45° FOV. Image size 2352x1568
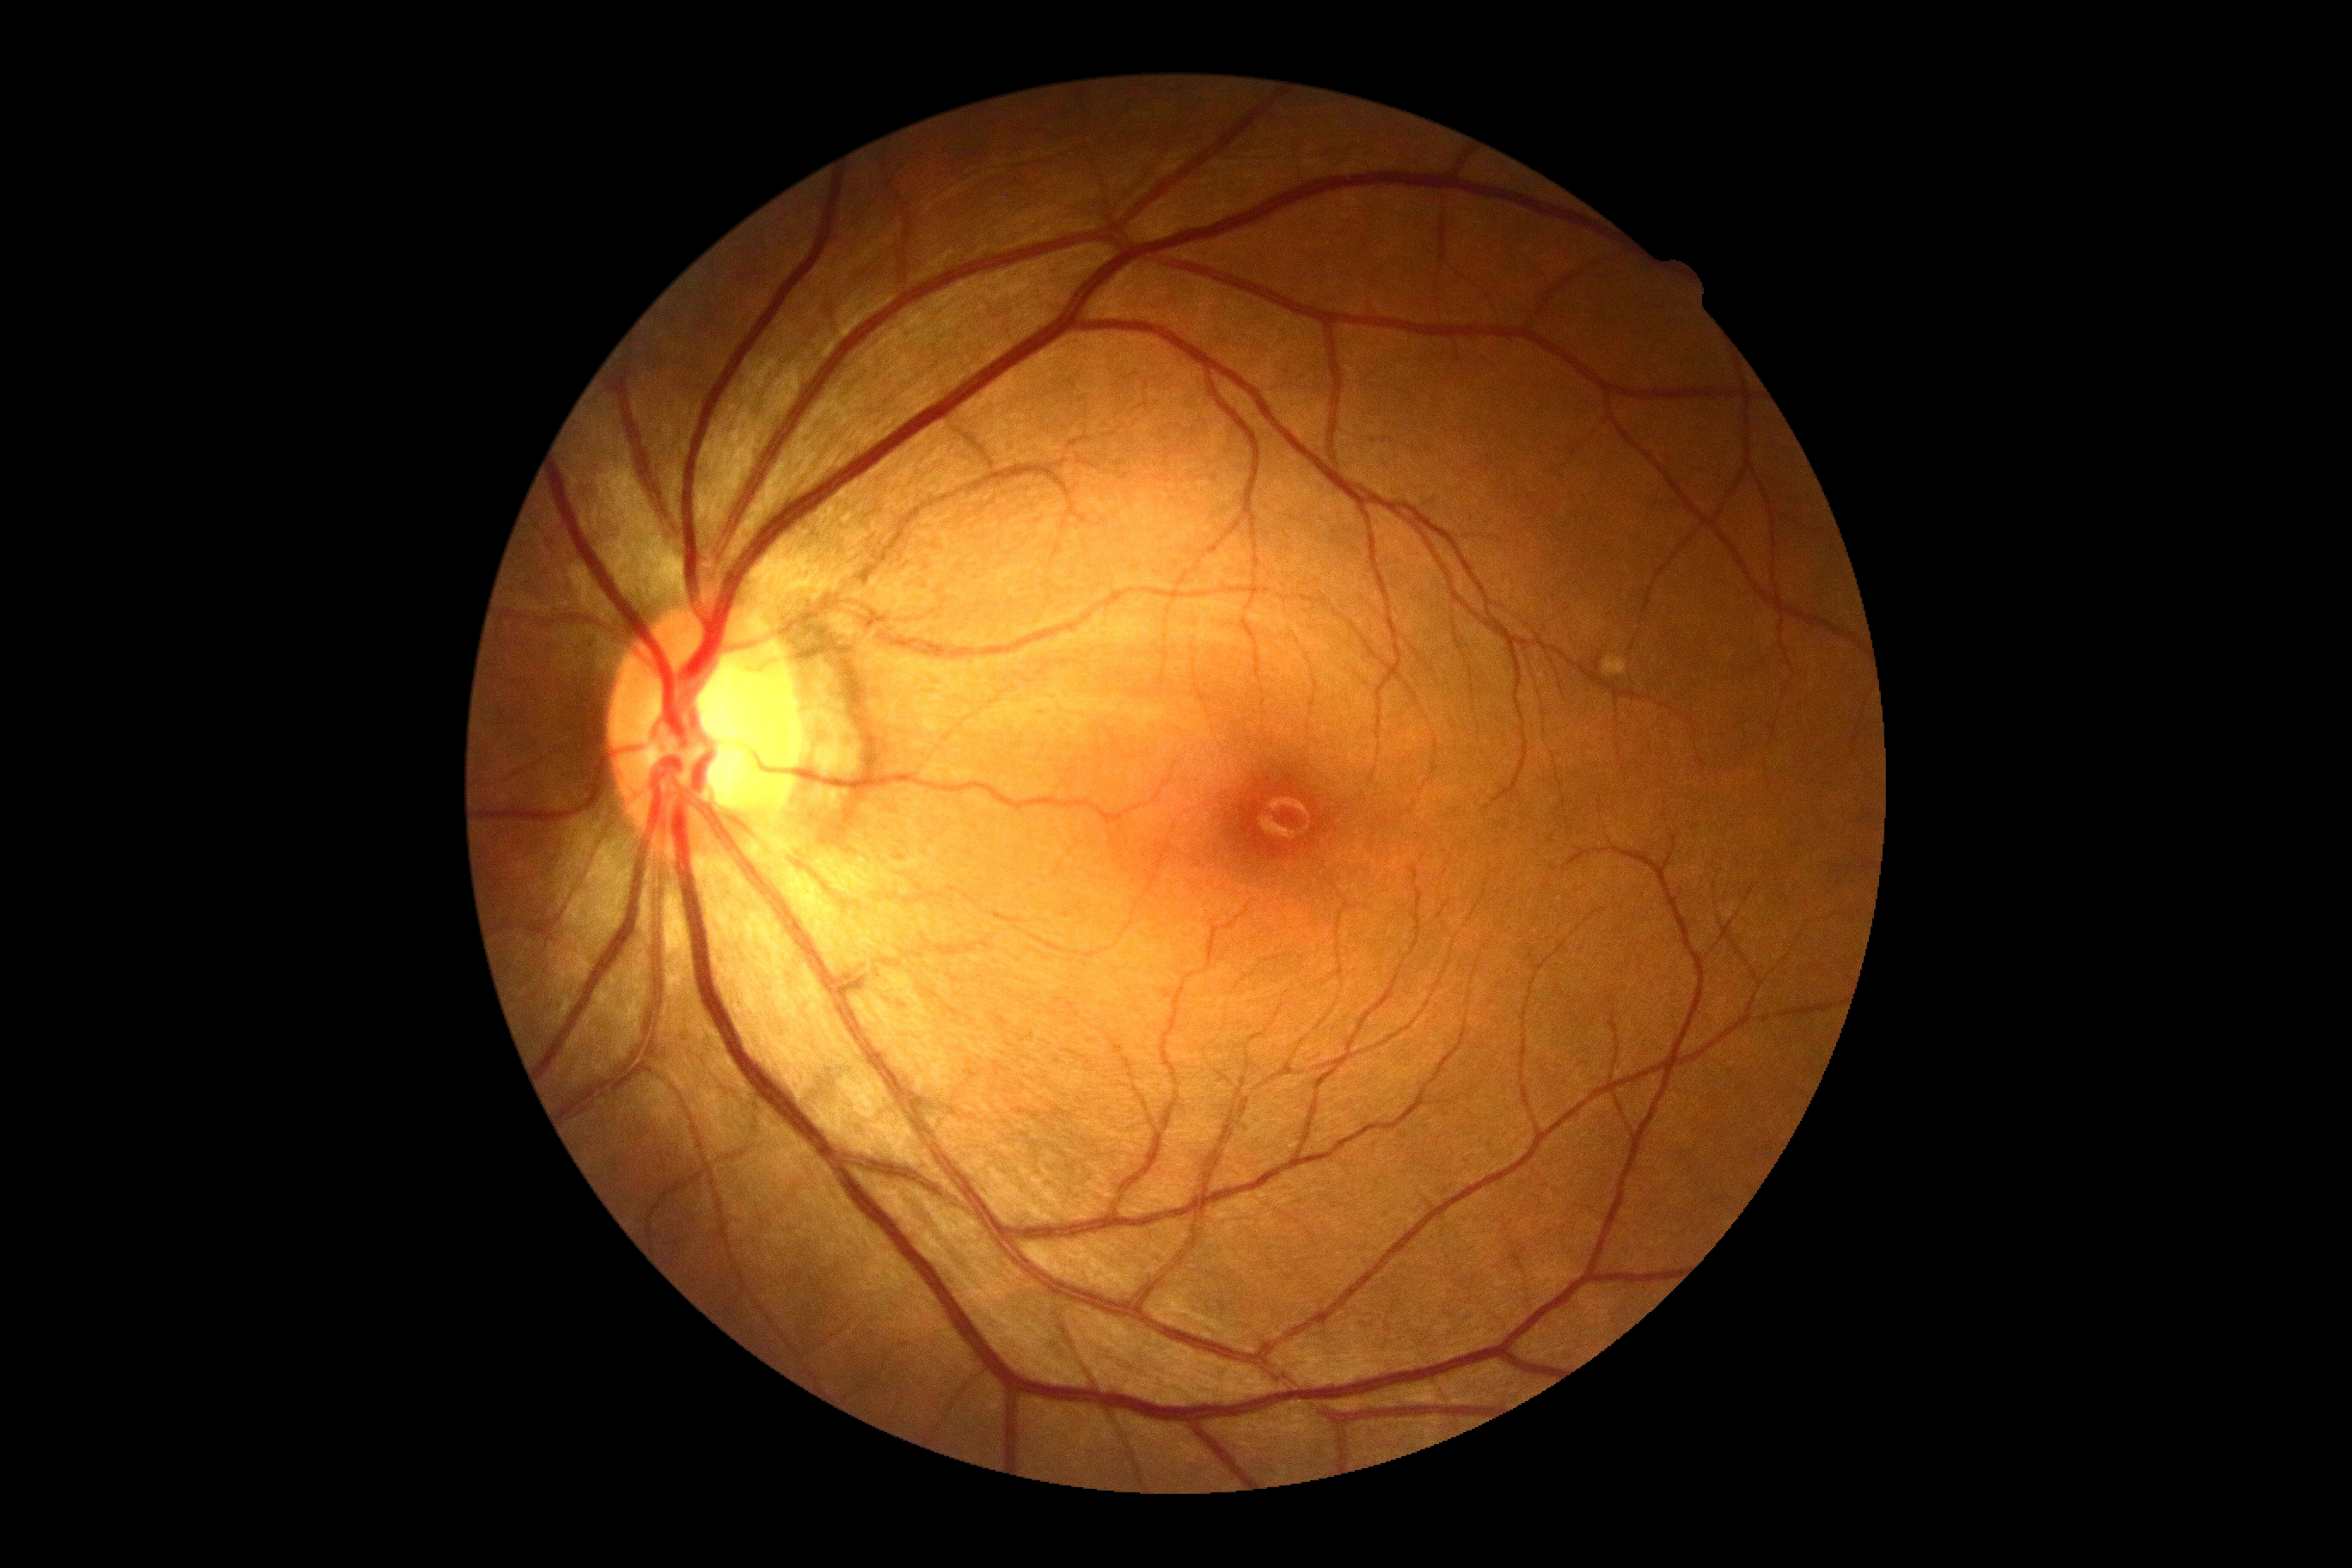
diabetic retinopathy severity@no apparent diabetic retinopathy (grade 0); DR impression@negative for DR.